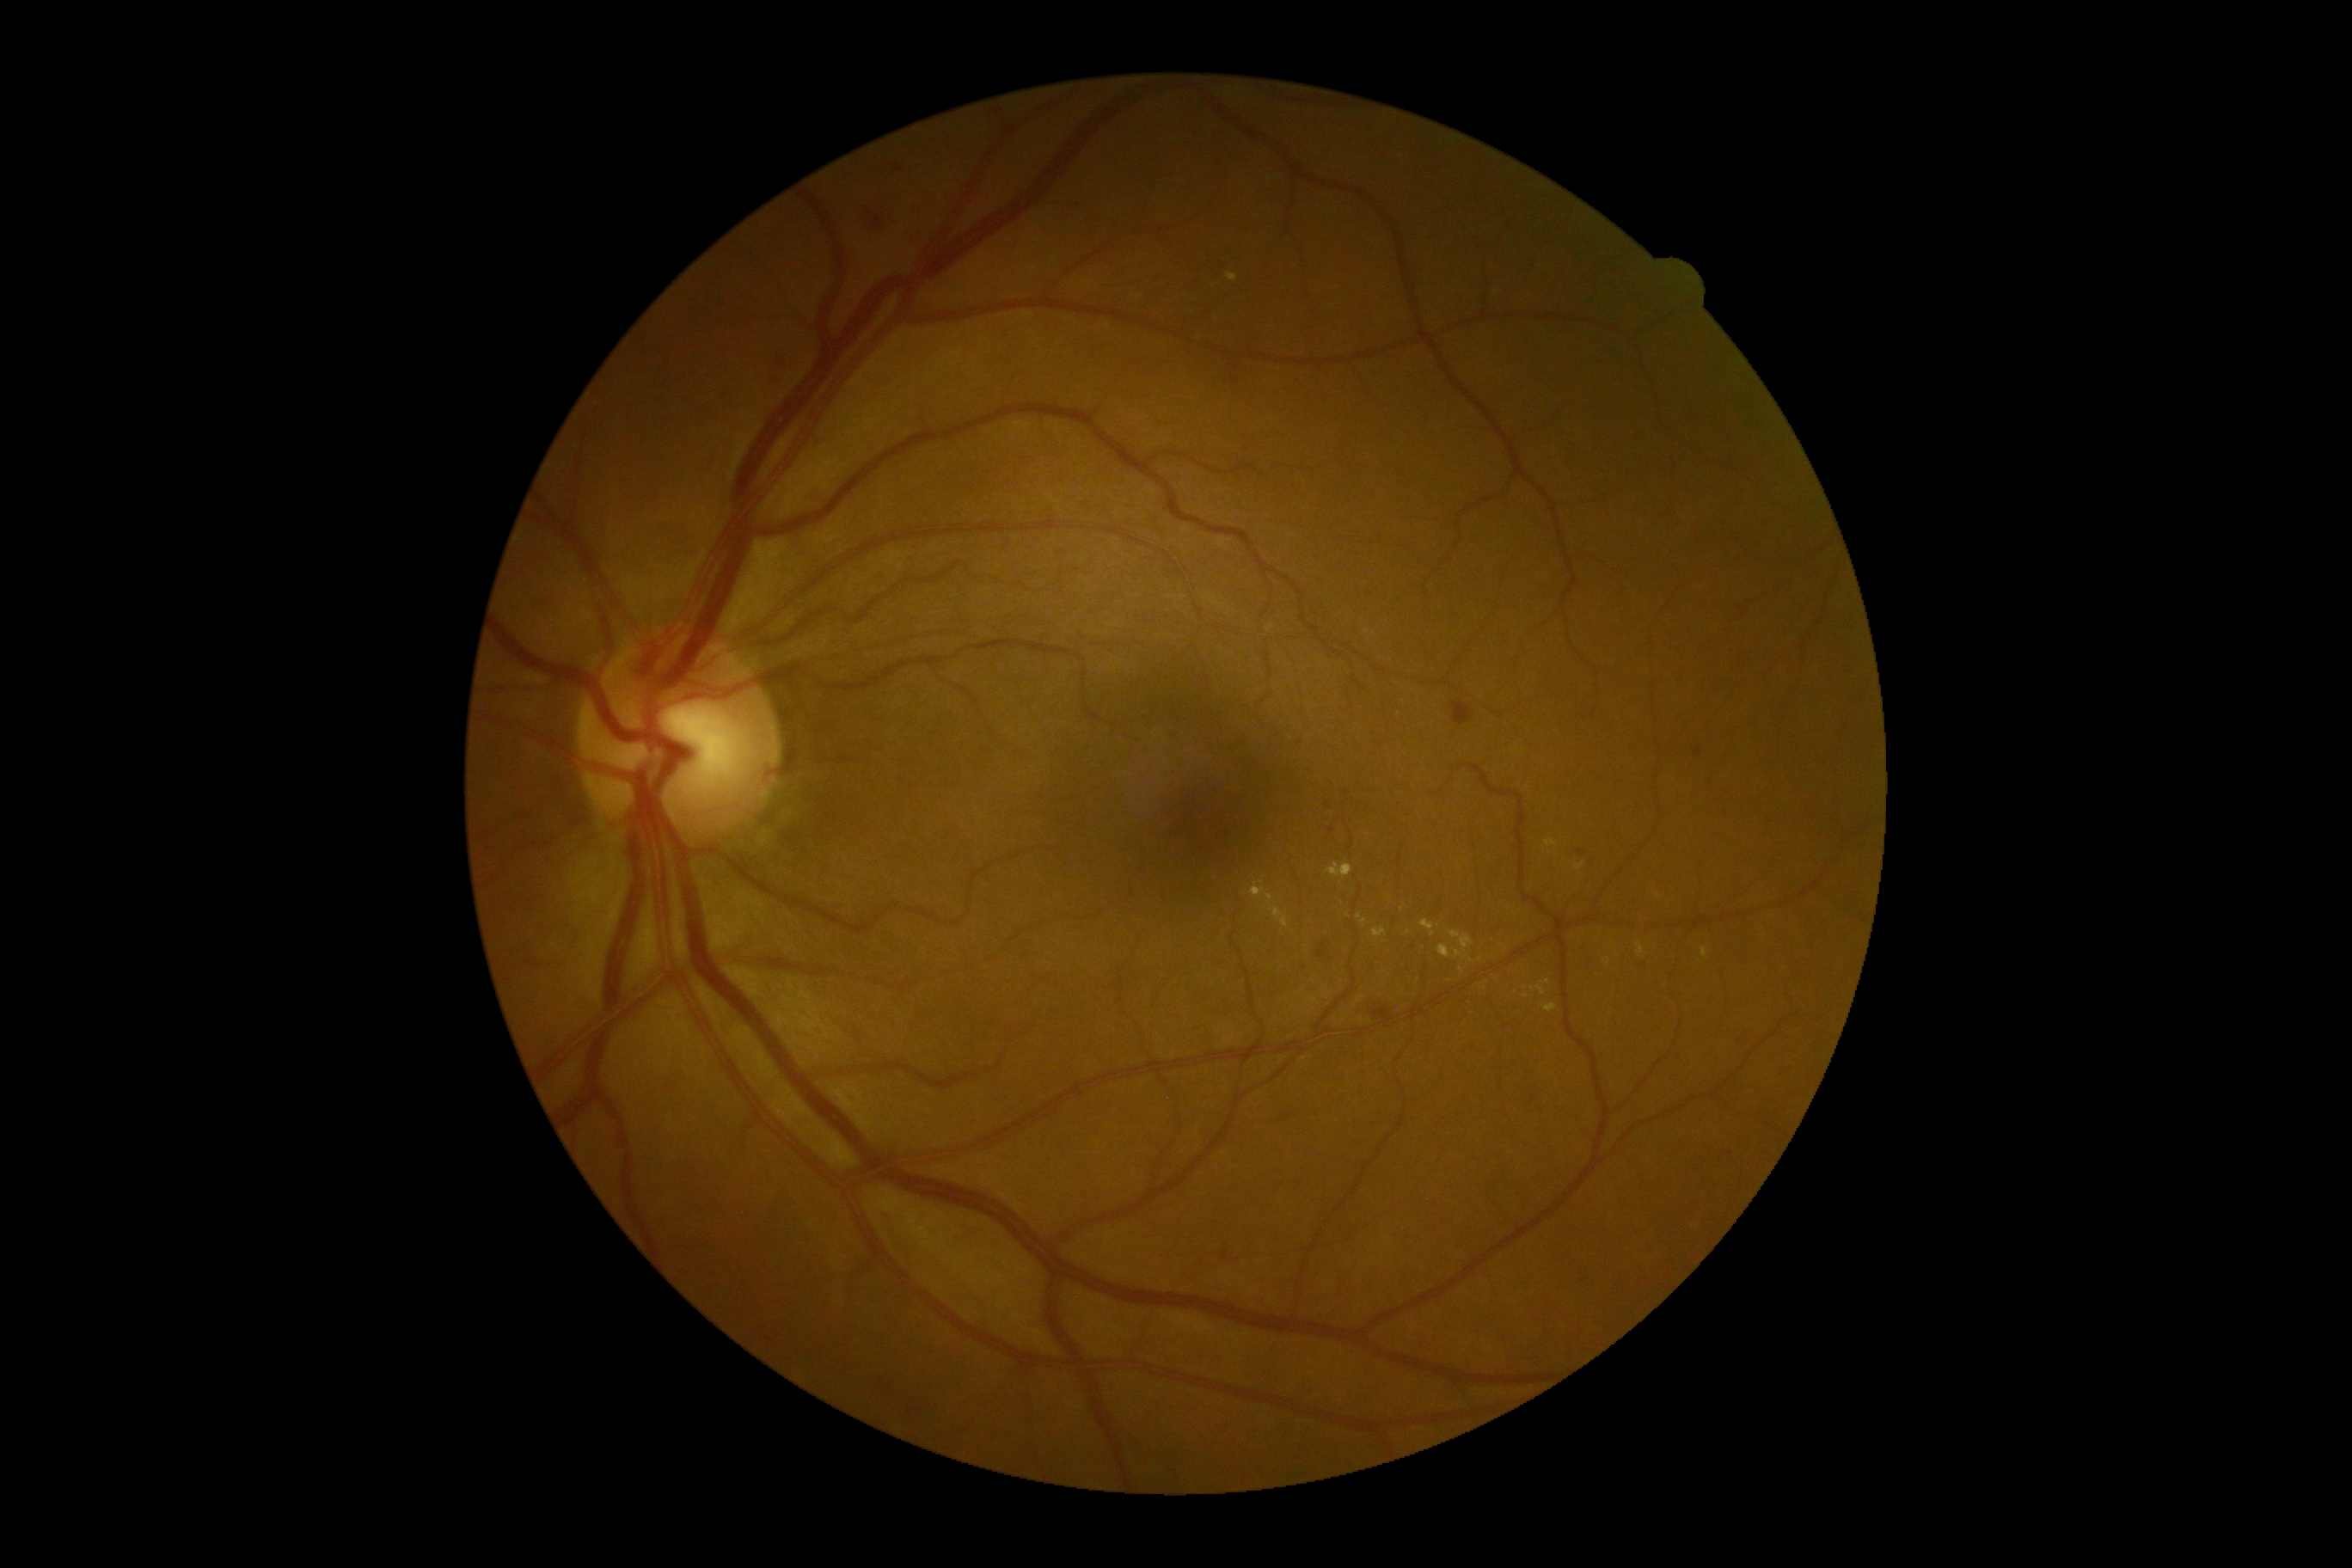 DR grade is moderate non-proliferative diabetic retinopathy (2) — more than just microaneurysms but less than severe NPDR. The retinopathy is classified as non-proliferative diabetic retinopathy.